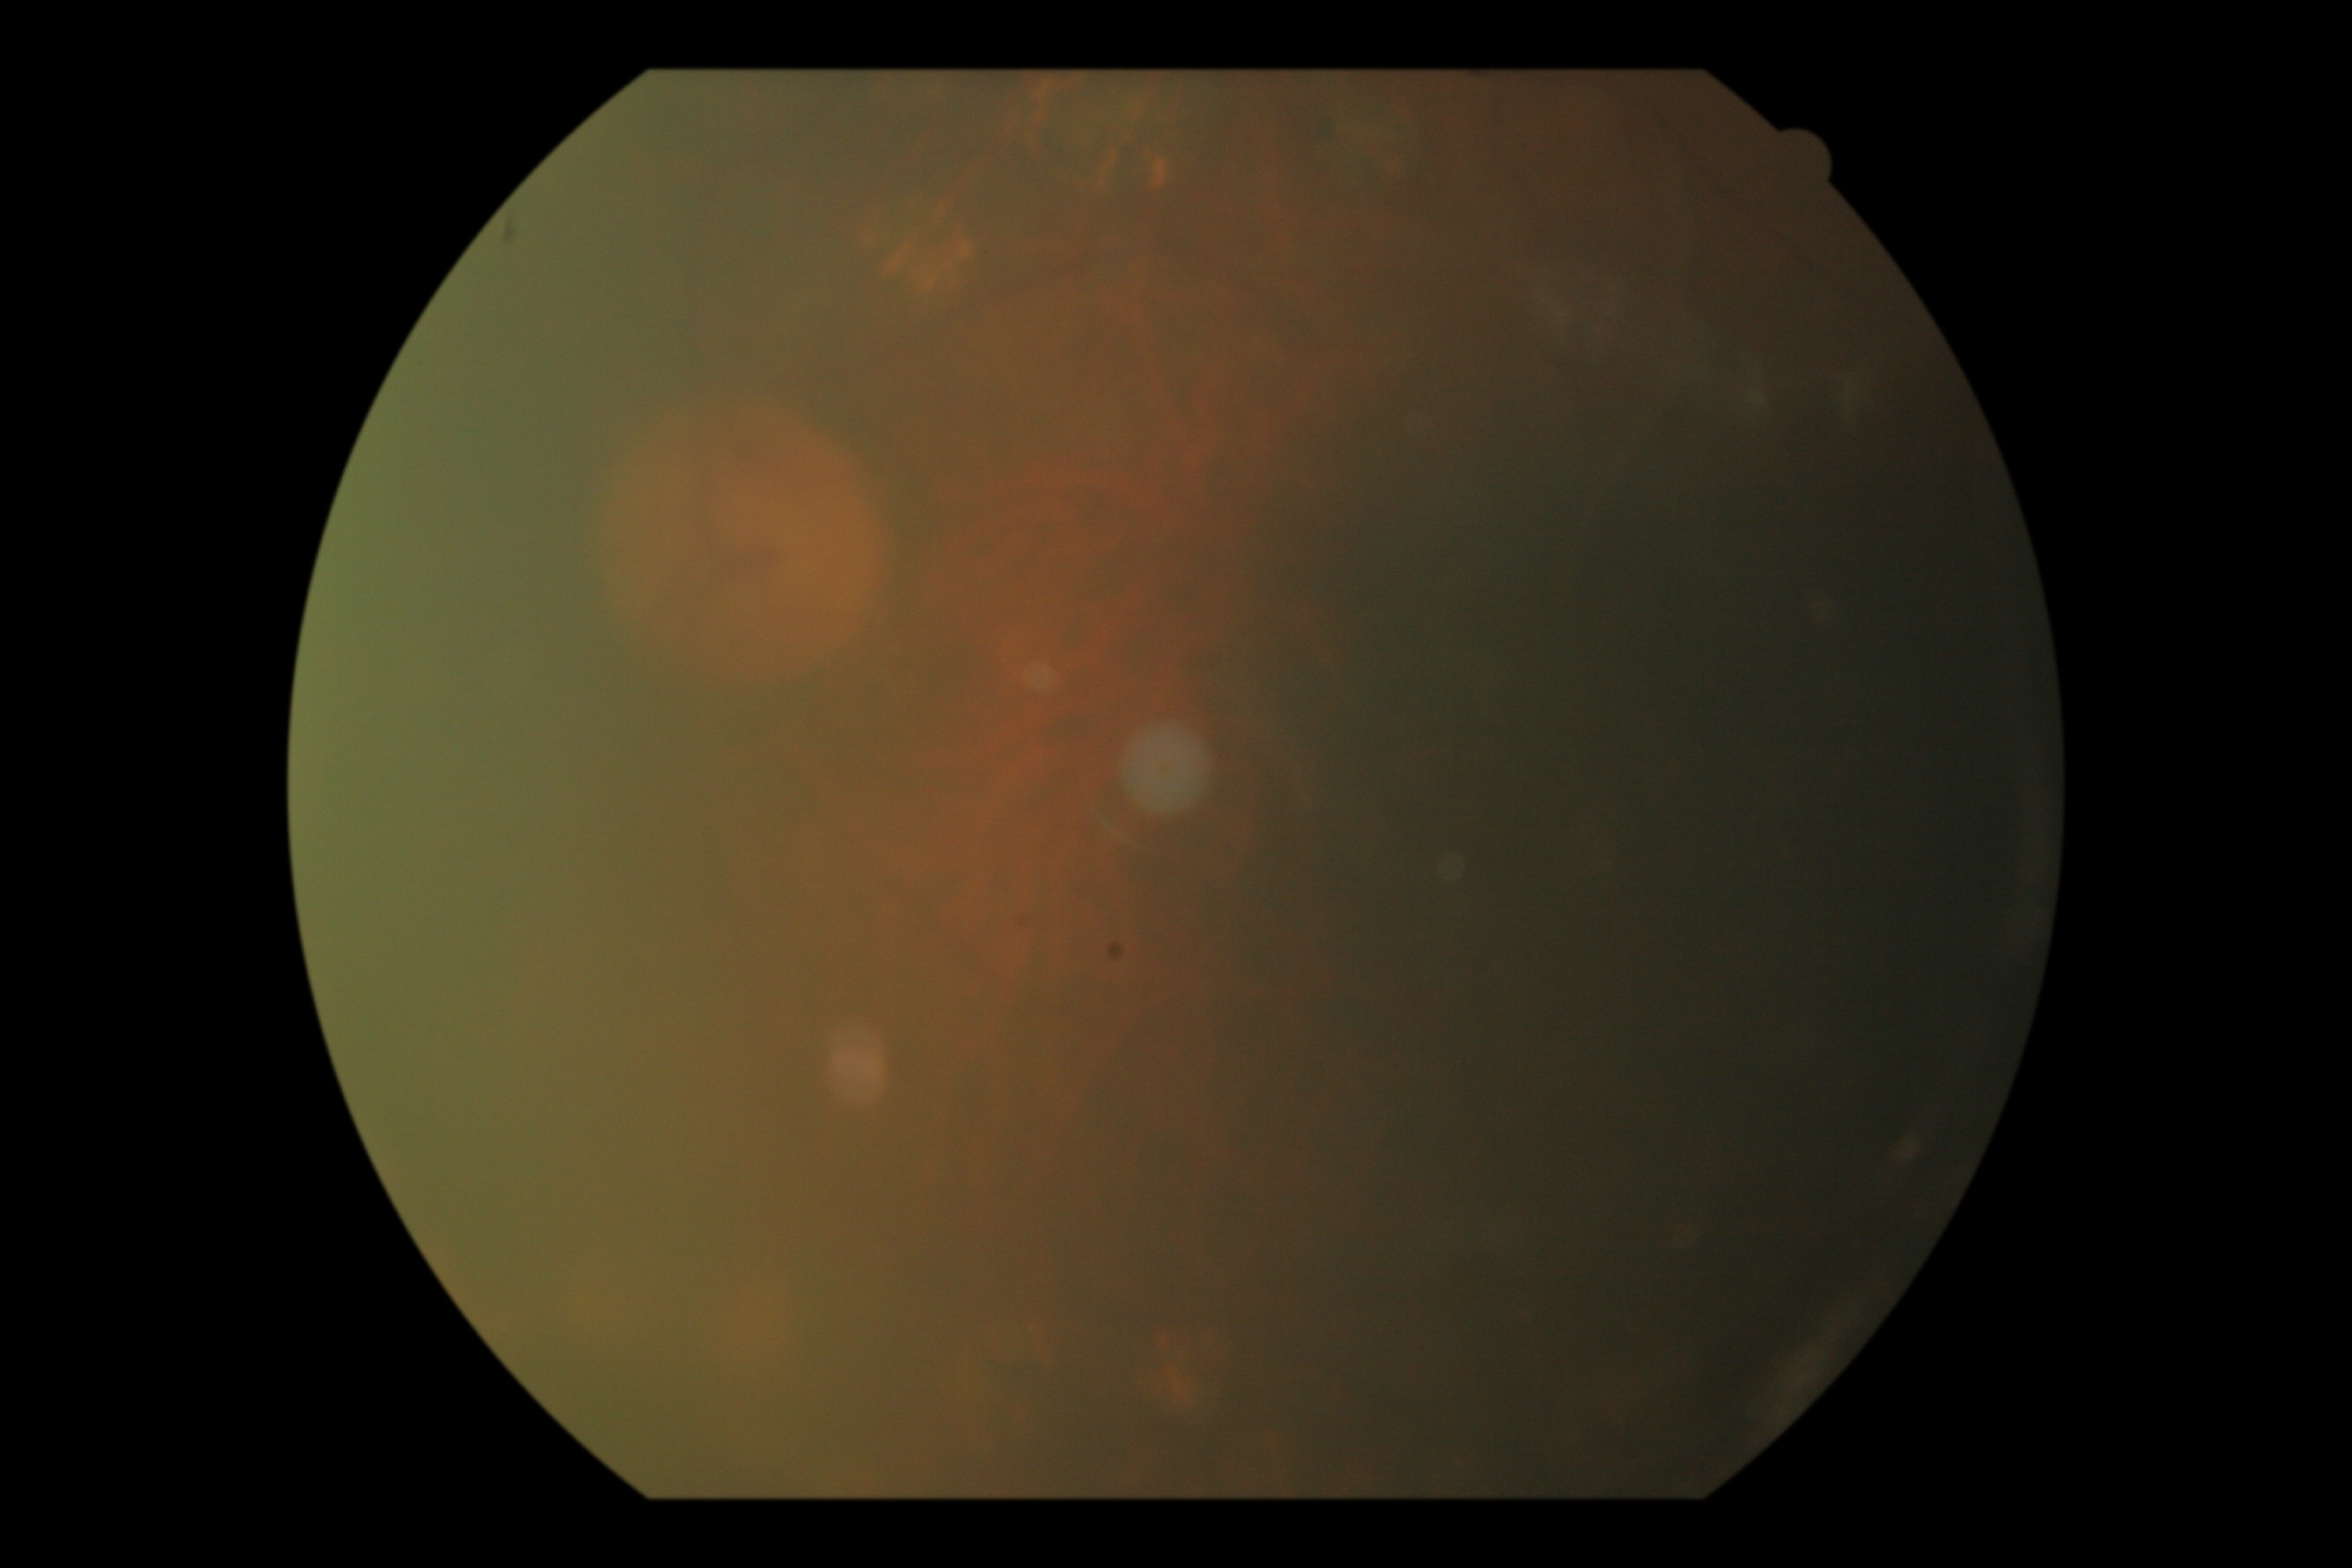 Diabetic retinopathy: ungradable due to poor image quality.